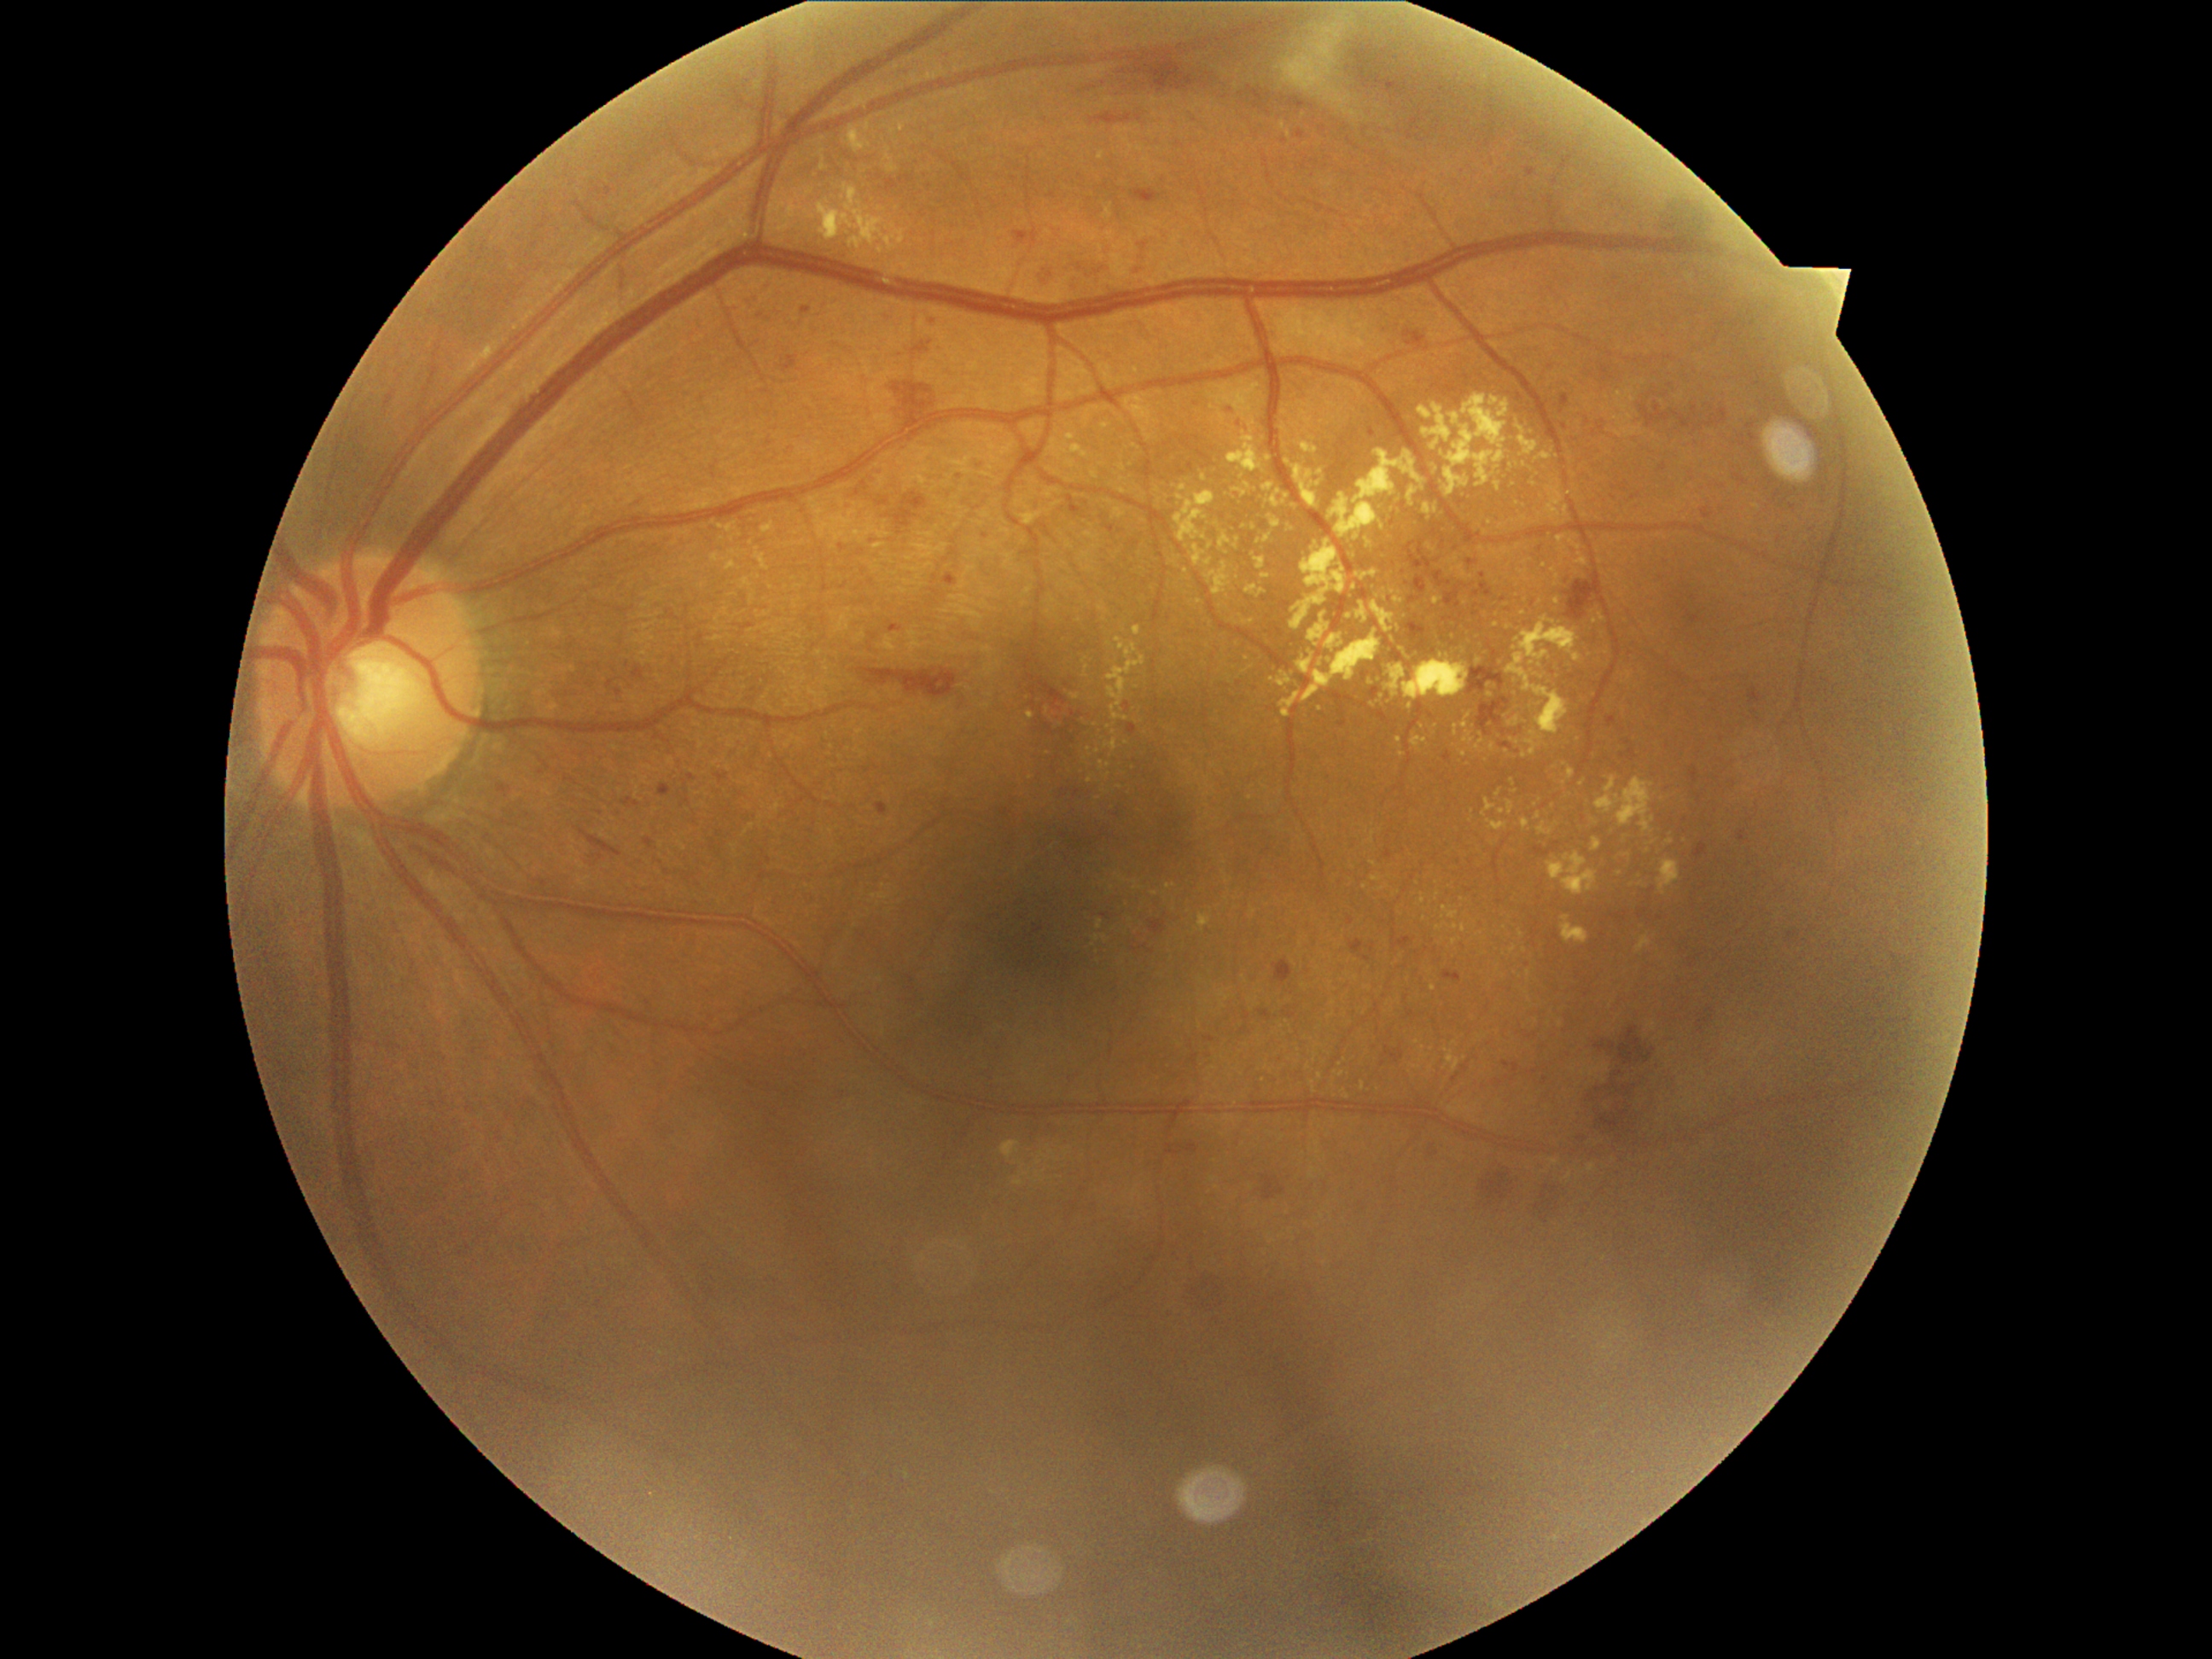
Diabetic retinopathy (DR): grade 2 (moderate NPDR) — more than just microaneurysms but less than severe NPDR
Selected lesions:
• hard exudates (EXs) (partial): 1098/153/1105/161; 1547/858/1564/880; 817/187/911/253; 1308/614/1330/648; 1260/573/1271/581; 1090/472/1098/480; 1537/824/1554/835; 1103/209/1114/219; 1487/820/1508/832
• Smaller EXs around (1758,506); (1519,692); (1523,518); (1371,683); (1252,912); (1479,662); (1098,799); (1124,468); (1227,553); (1378,679)
• microaneurysms (MAs) (partial): 1397/940/1411/952; 1749/434/1757/443; 929/317/940/329; 1607/716/1617/728; 1235/419/1245/429; 1788/933/1798/941; 687/769/699/786; 803/308/812/315; 1336/713/1351/728; 1733/475/1749/486; 1525/168/1537/177; 873/801/894/817; 1348/917/1354/926; 1747/424/1755/431
• Smaller MAs around (1411,101); (1751,449); (1630,744)